NIDEK AFC-230 fundus camera: 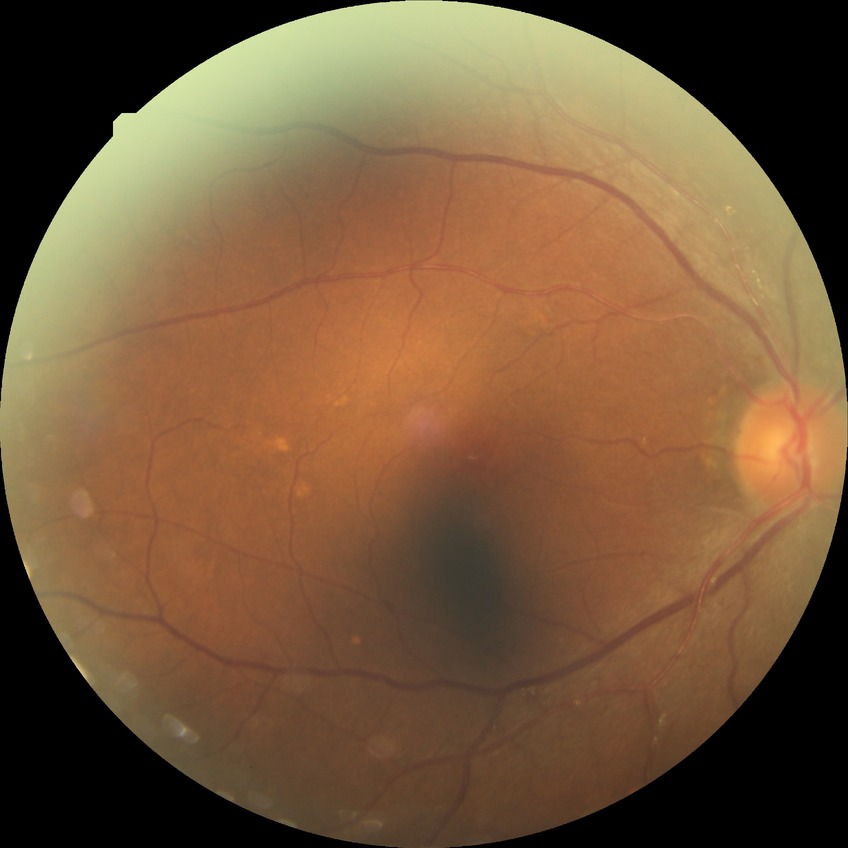

Annotations:
- DR severity: NDR
- DR impression: no apparent DR